2352 x 1568 pixels:
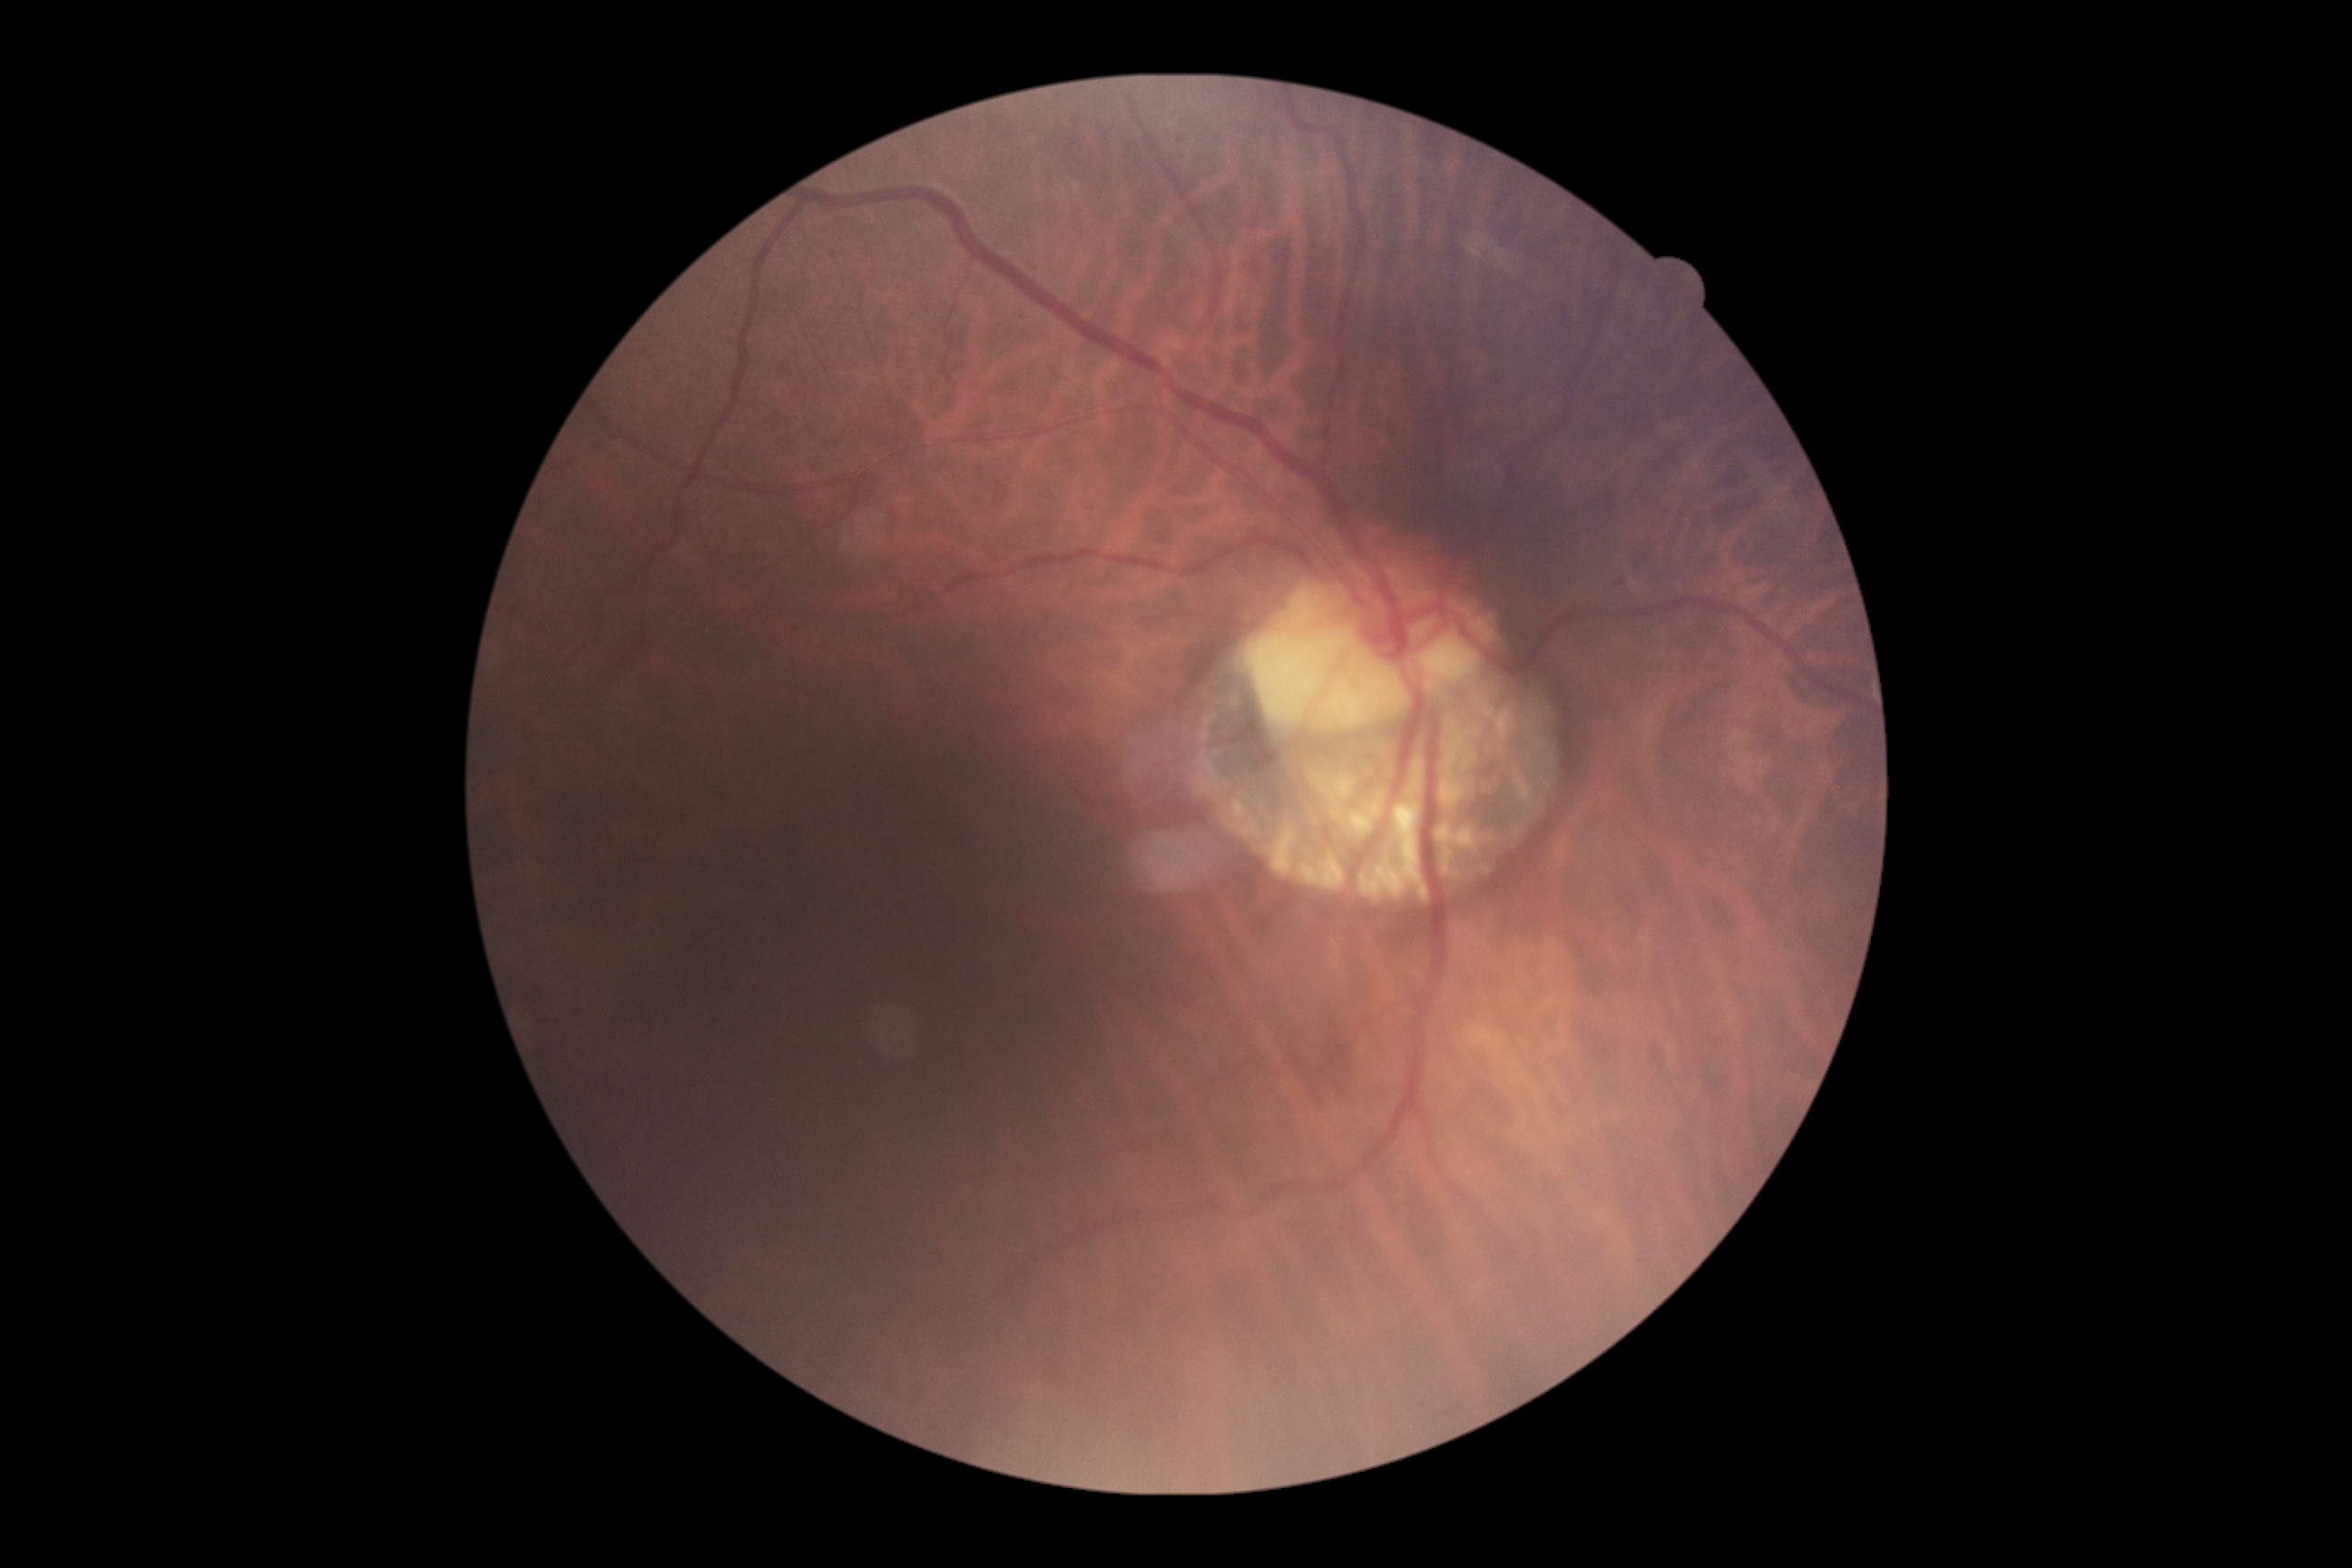 DR grade: 1 (mild NPDR).